Color fundus image · 848x848px
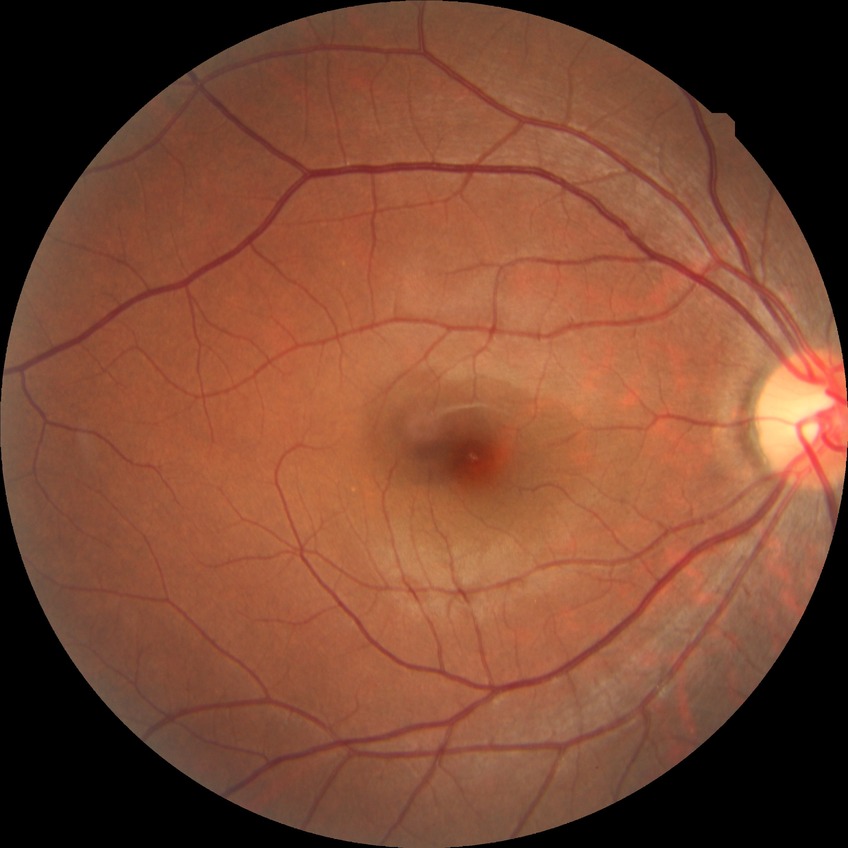

diabetic retinopathy severity=no diabetic retinopathy.